Color fundus image — 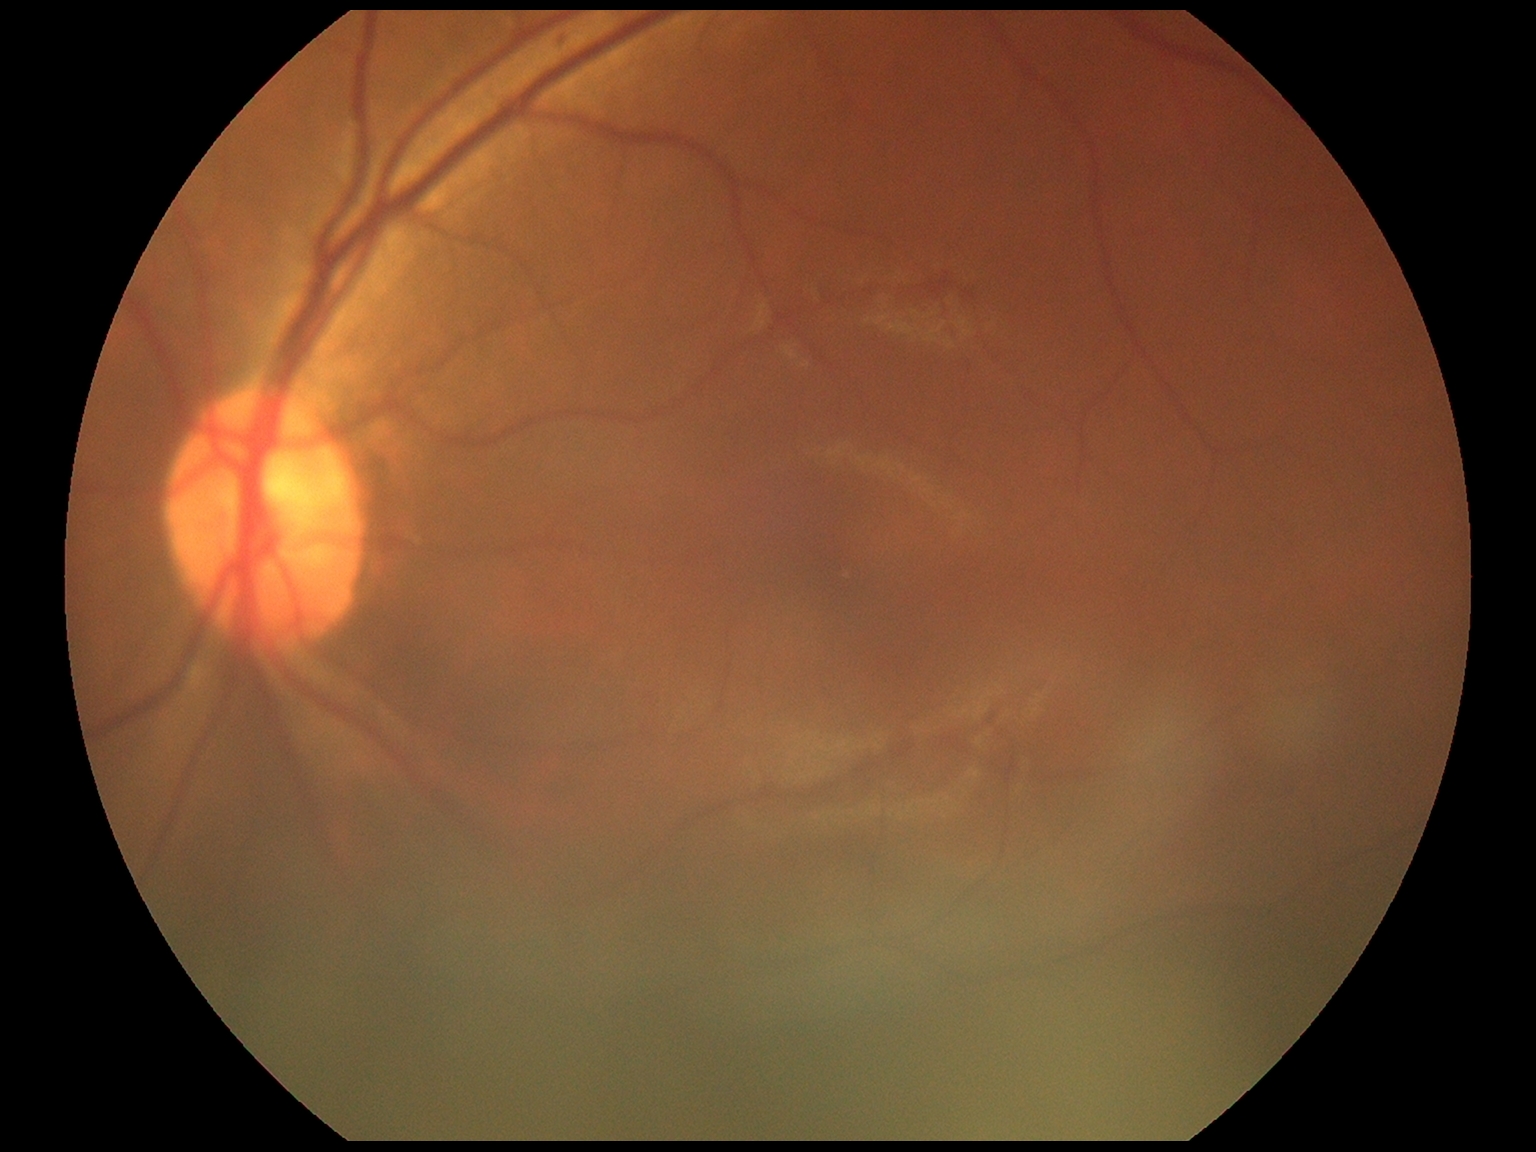

DR@1, DR class@non-proliferative diabetic retinopathy.